Retinal fundus photograph. Camera: Forus 3Nethra Classic
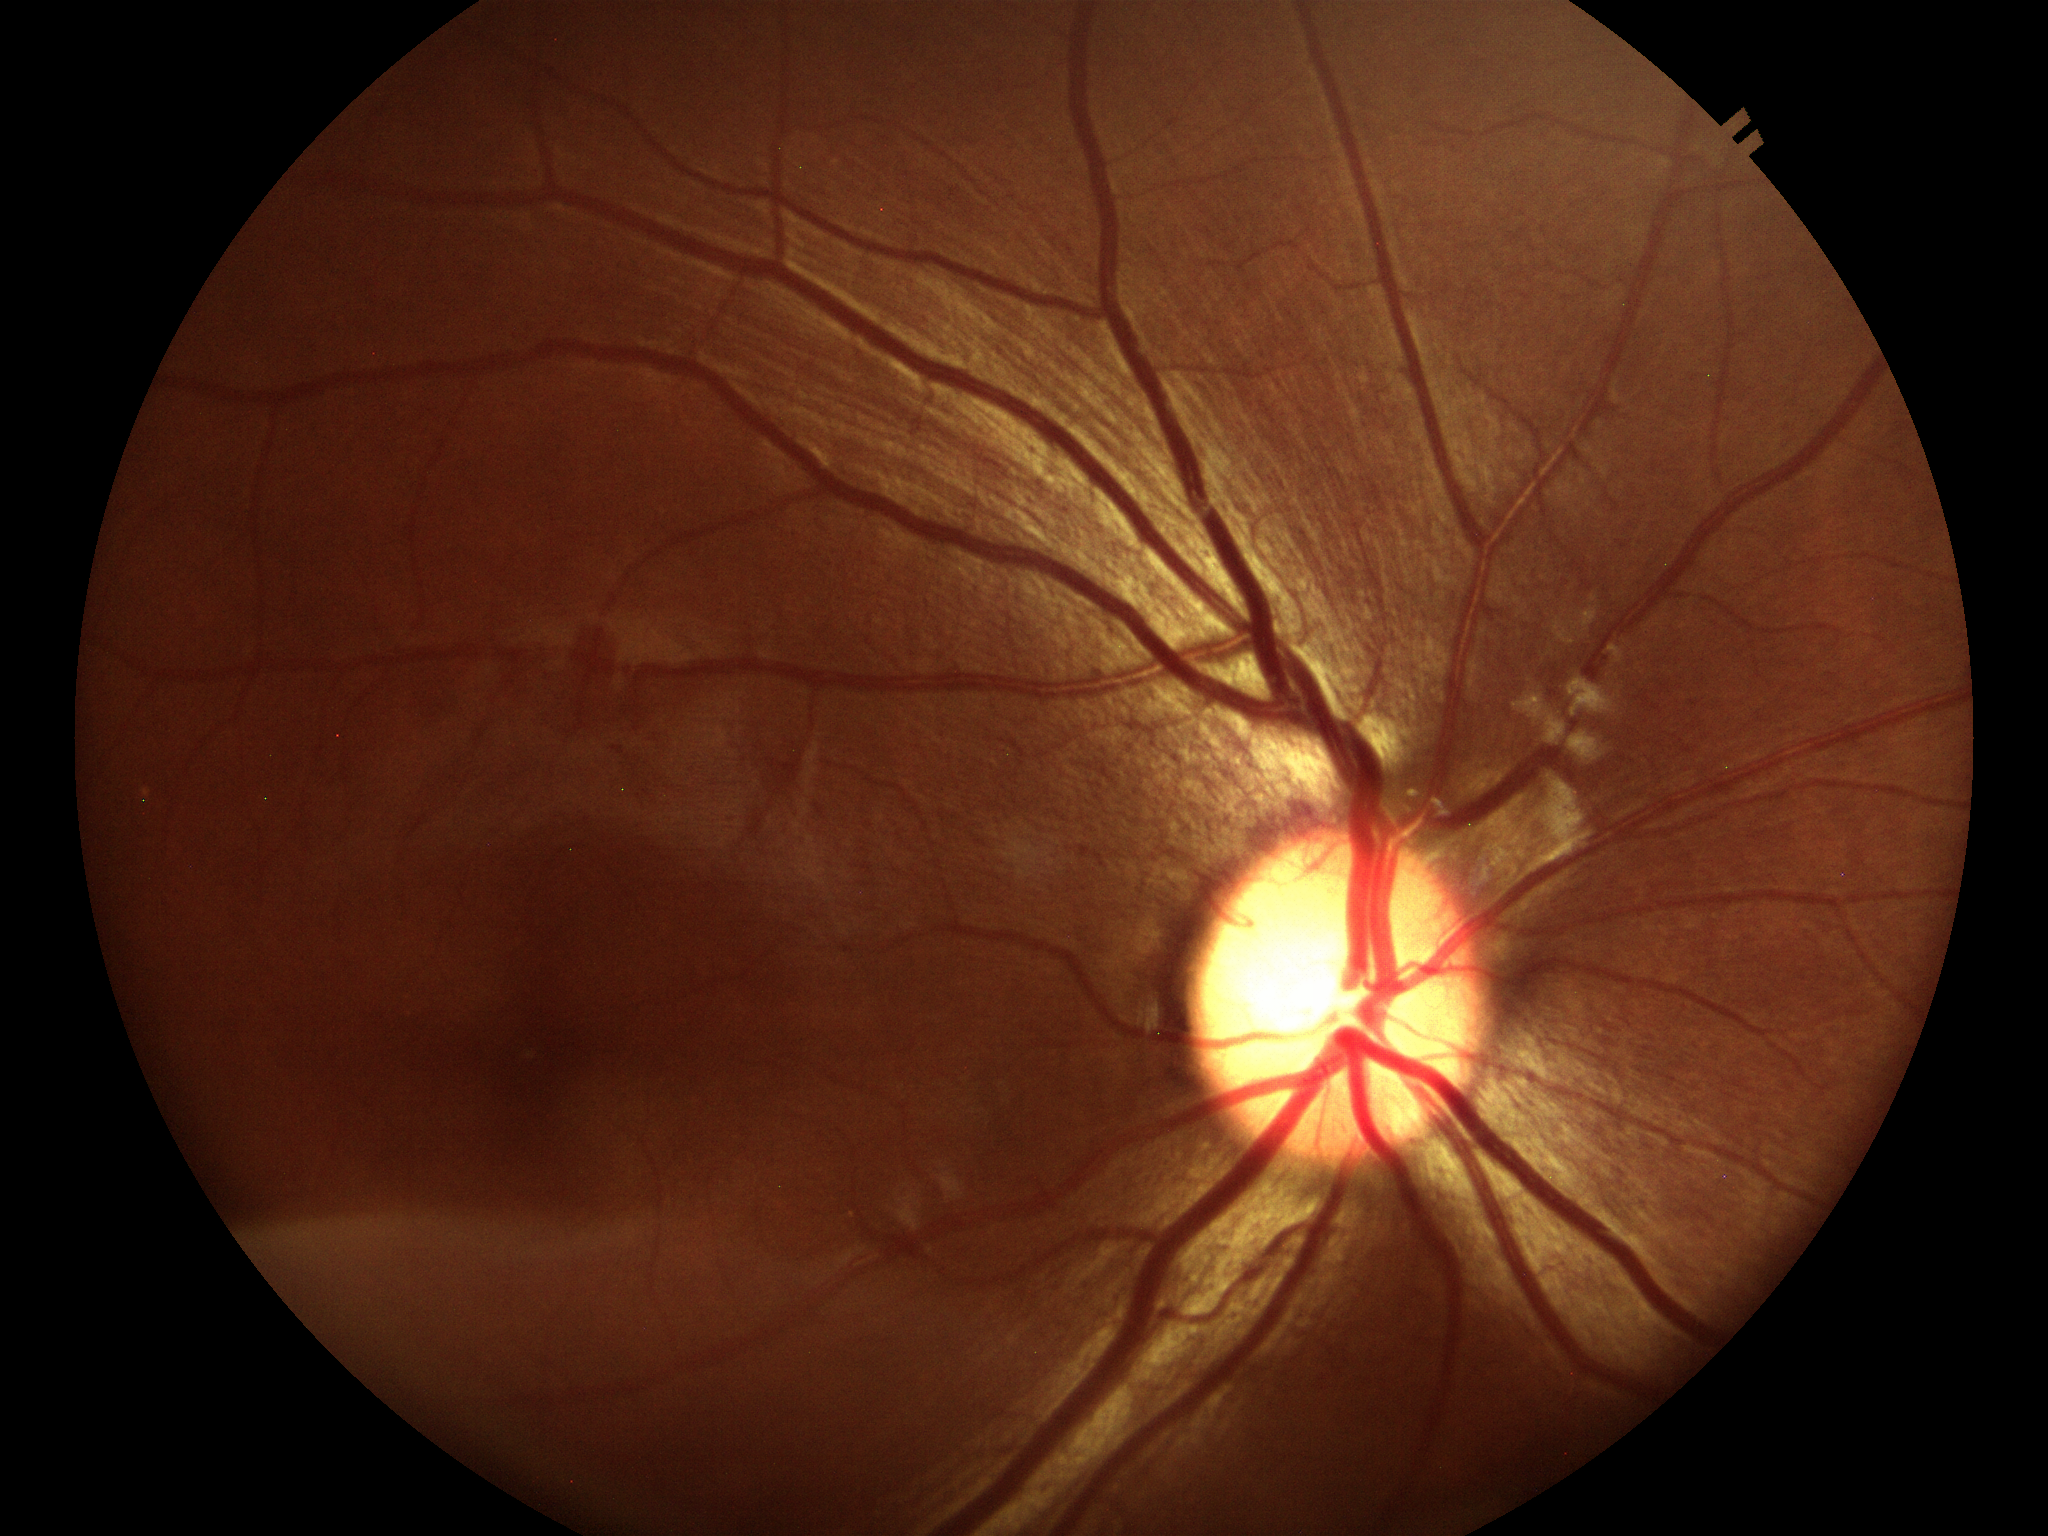

  vcdr: 0.57
  glaucoma_decision: not suspect
  hcdr: 0.60